45° field of view, color fundus photograph: 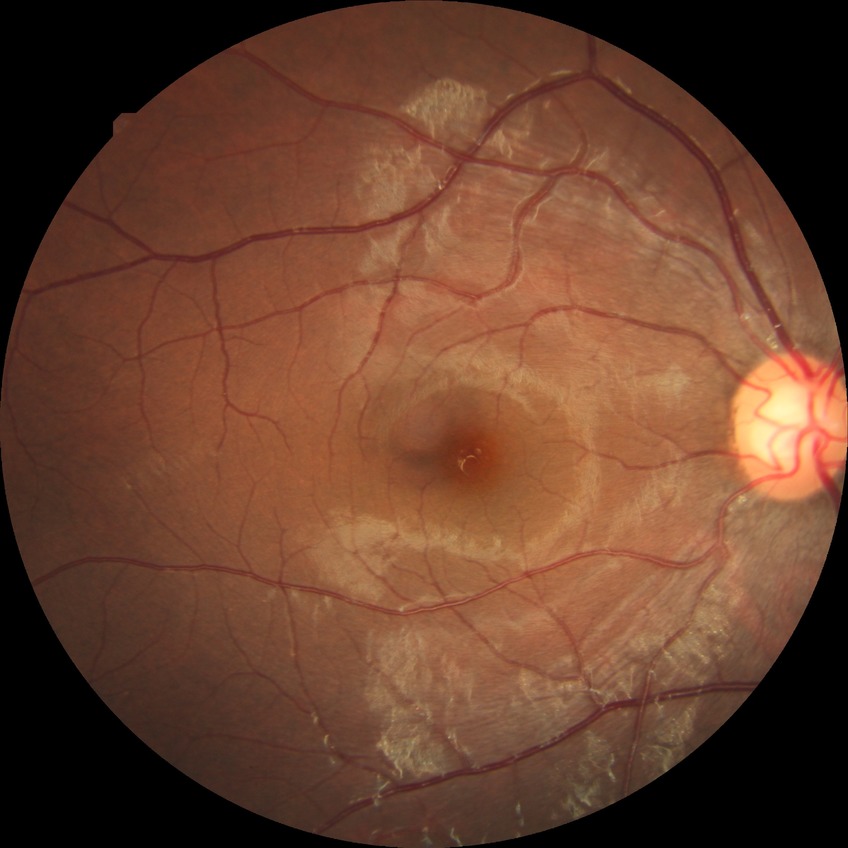
Diabetic retinopathy (DR): NDR (no diabetic retinopathy).